848 by 848 pixels; FOV: 45 degrees; NIDEK AFC-230 fundus camera; without pupil dilation:
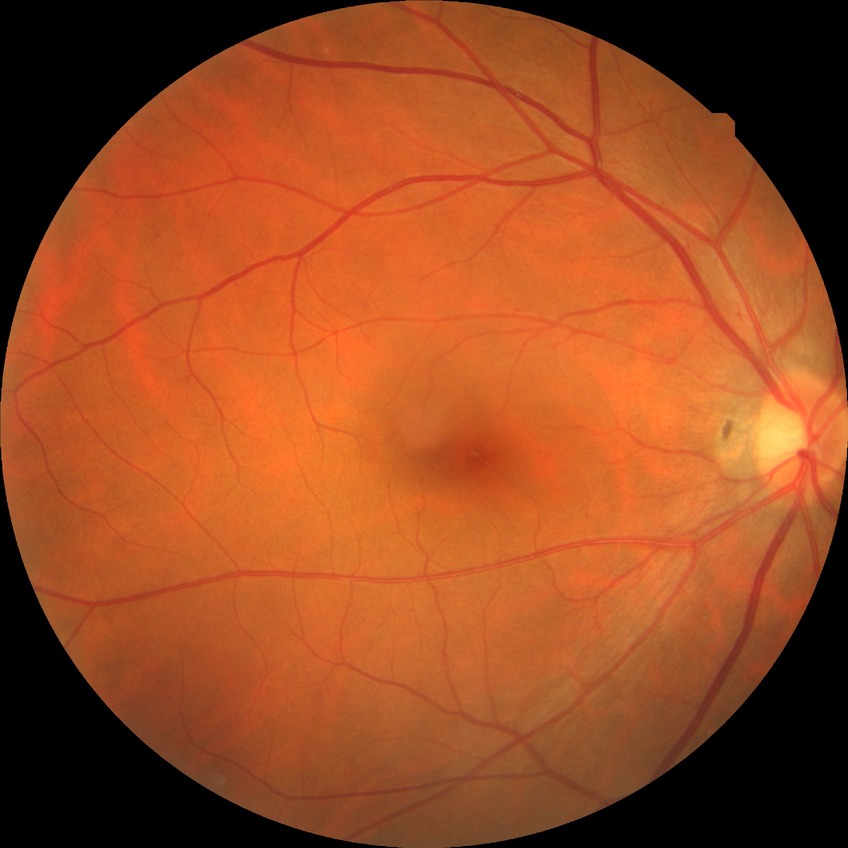 retinopathy grade: no diabetic retinopathy.